Retinal fundus photograph, 2352 by 1568 pixels.
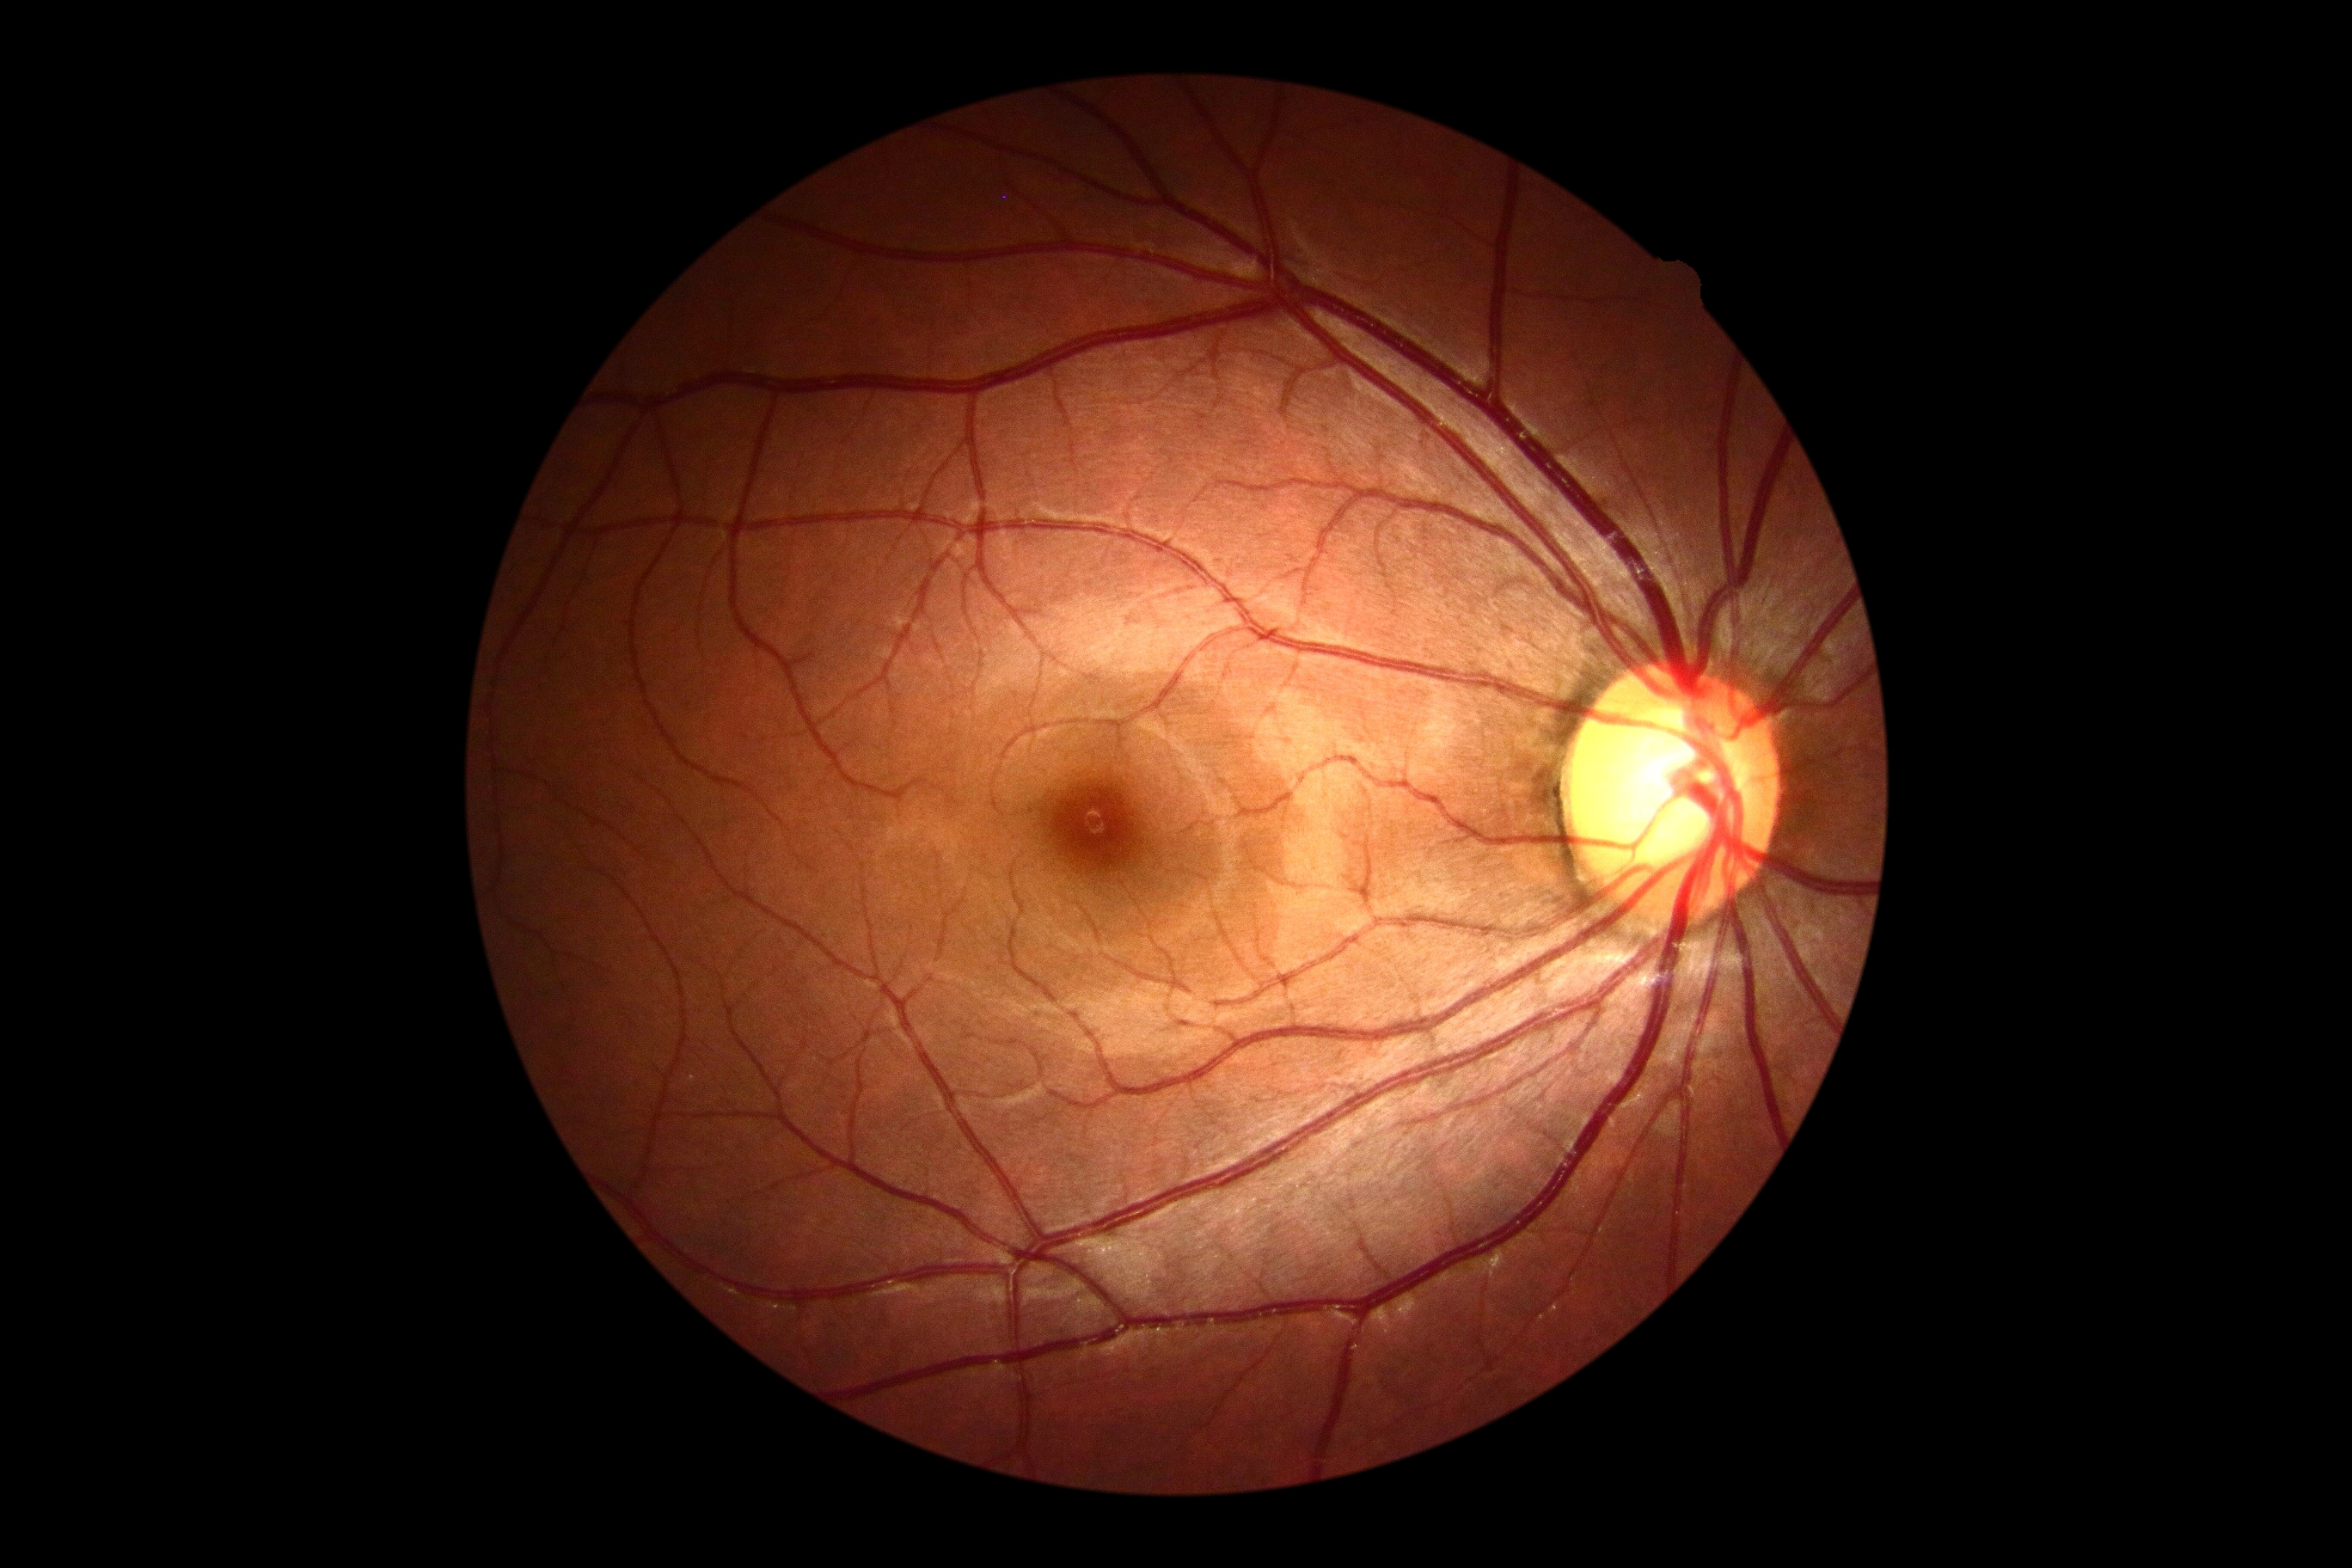
DR stage is grade 0 — no visible signs of diabetic retinopathy.